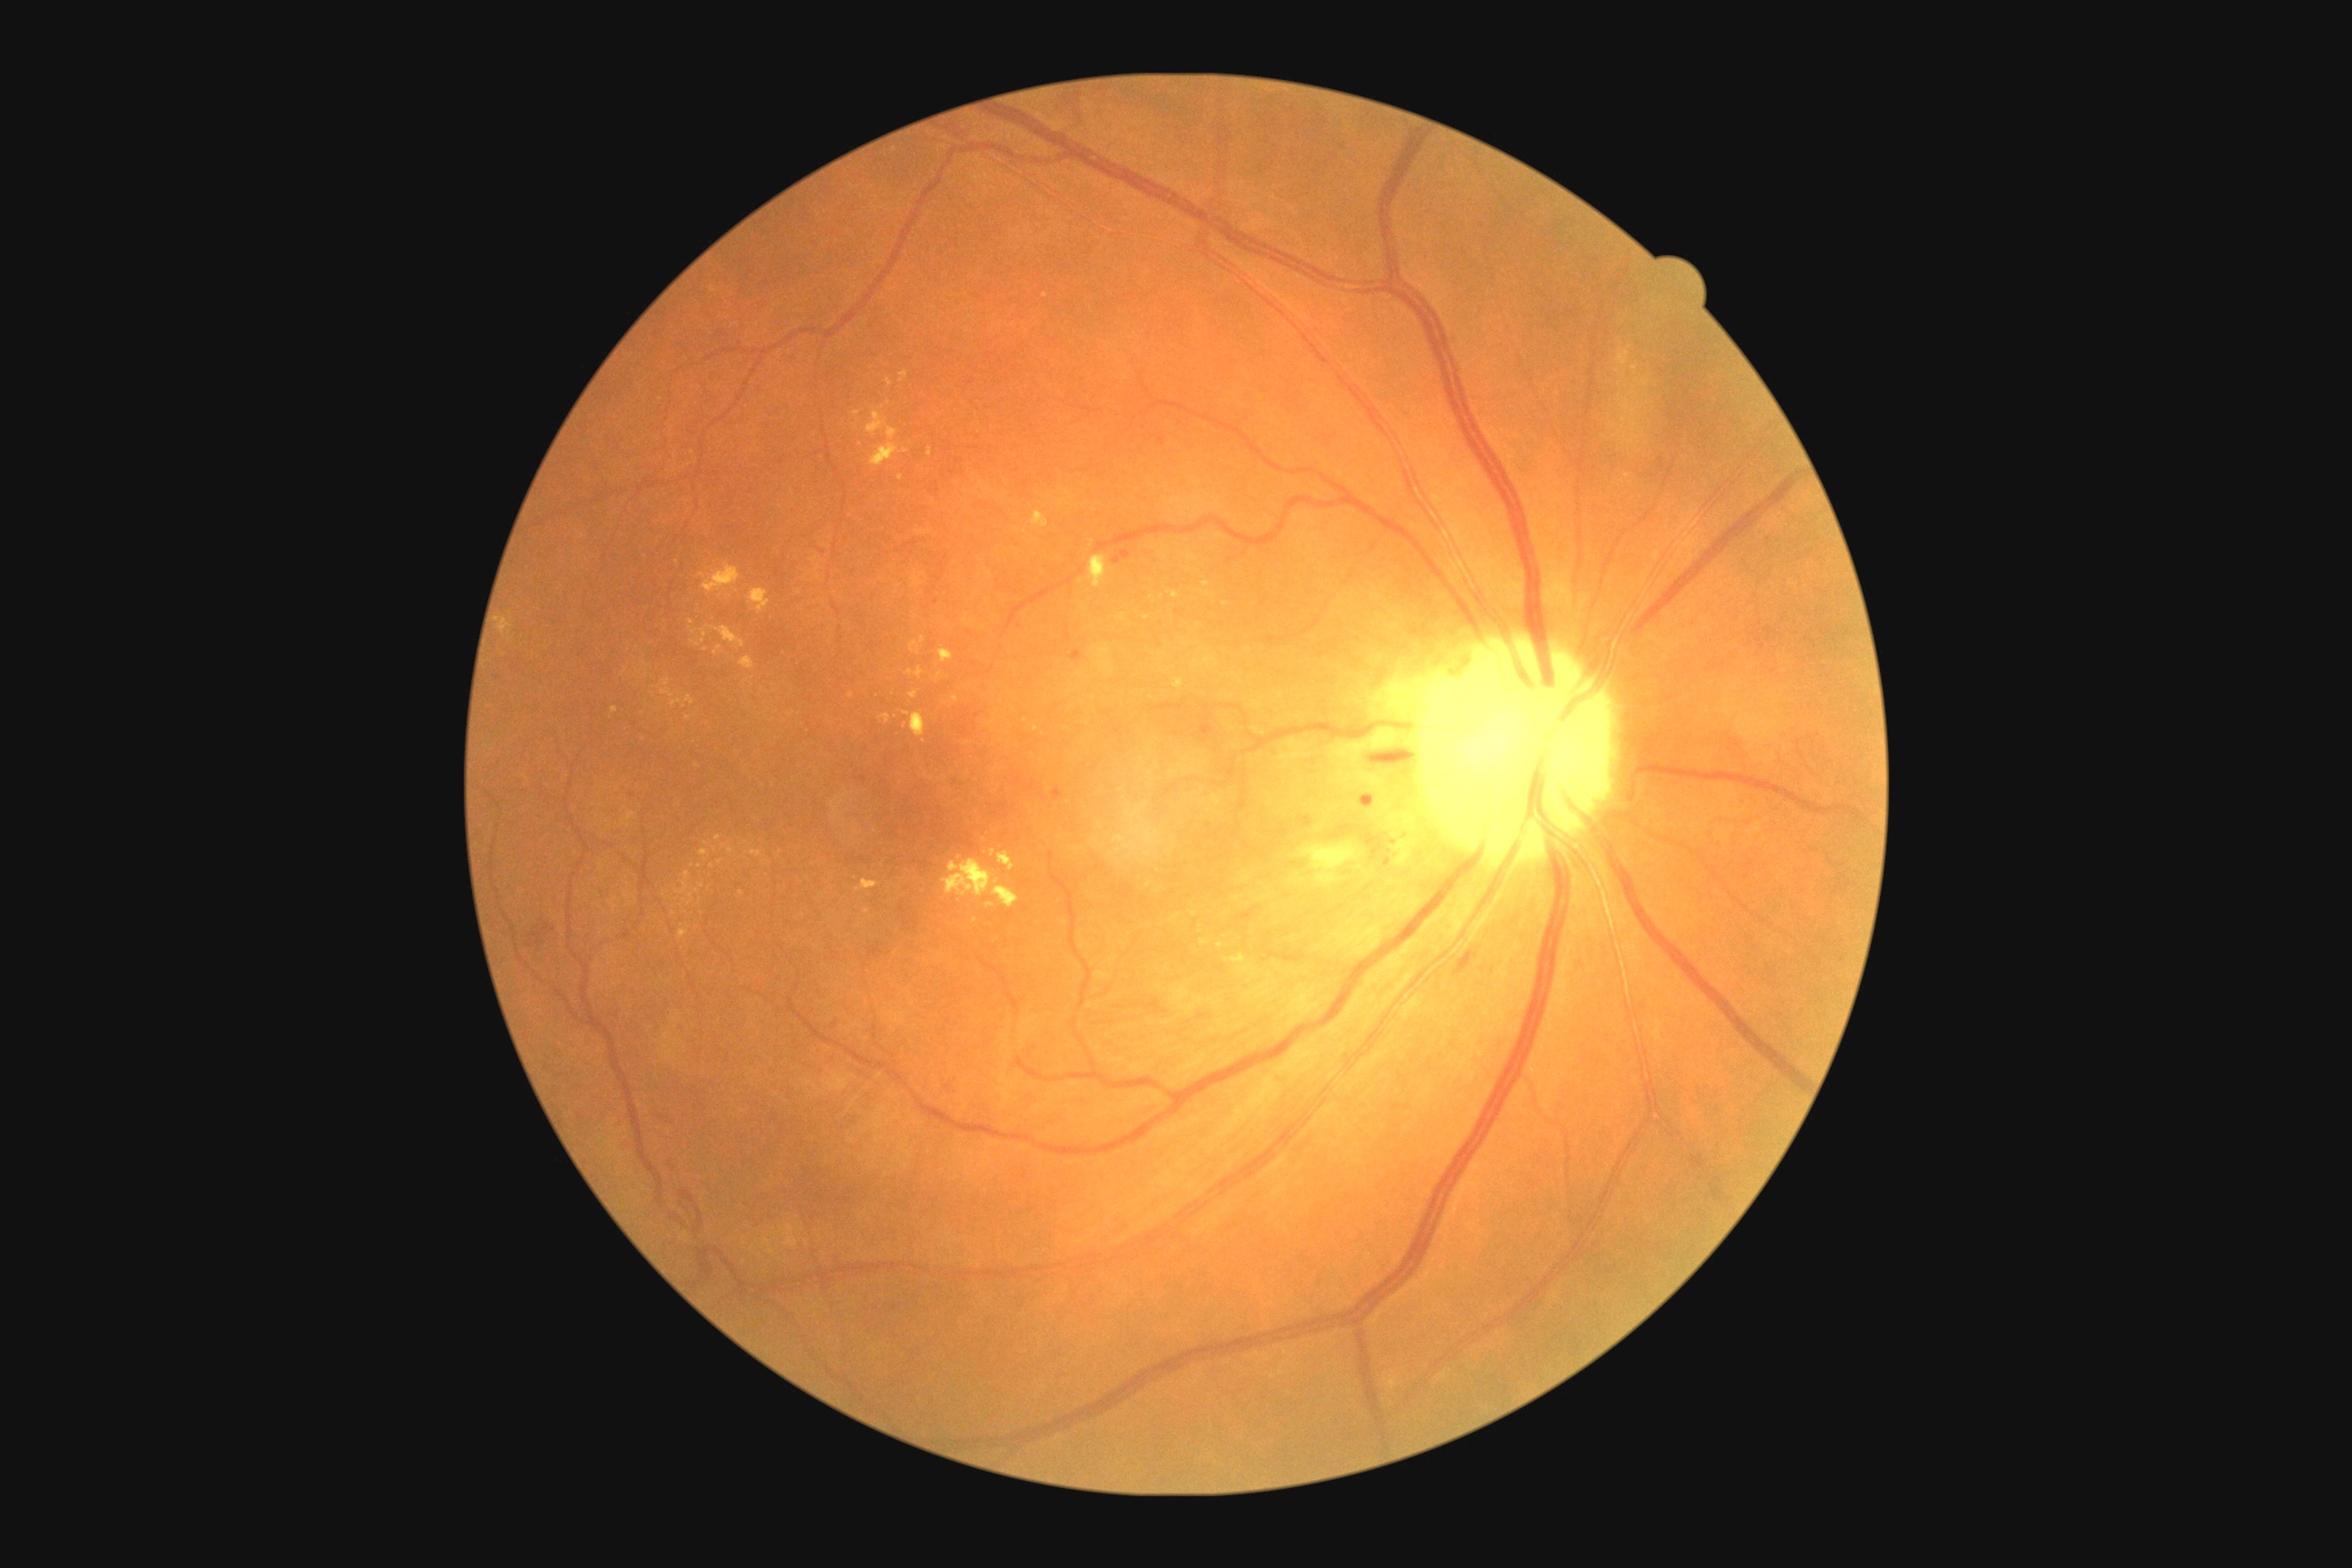
{"partial": true, "dr_grade": 2, "lesions": {"he": [[1367, 747, 1413, 758], [696, 1206, 703, 1224], [531, 921, 554, 946], [680, 1190, 696, 1202], [1455, 950, 1478, 975], [698, 1250, 714, 1280]], "ma": [[1362, 794, 1375, 803], [1113, 558, 1122, 564], [1204, 725, 1215, 734], [1072, 651, 1083, 662], [1054, 789, 1064, 799]], "ma_small_centers": [[1388, 861], [1127, 556], [937, 601], [1393, 841]], "se": null, "ex": [[623, 807, 636, 821], [870, 444, 899, 467], [879, 714, 892, 723], [908, 692, 917, 700], [943, 859, 1019, 908], [986, 903, 995, 908], [678, 930, 689, 939], [1175, 680, 1184, 689], [856, 879, 879, 892]], "ex_small_centers": [[643, 739], [1558, 395], [717, 839], [665, 894], [697, 767], [712, 866], [1220, 945], [940, 677], [1008, 734], [1149, 885], [703, 575]]}}